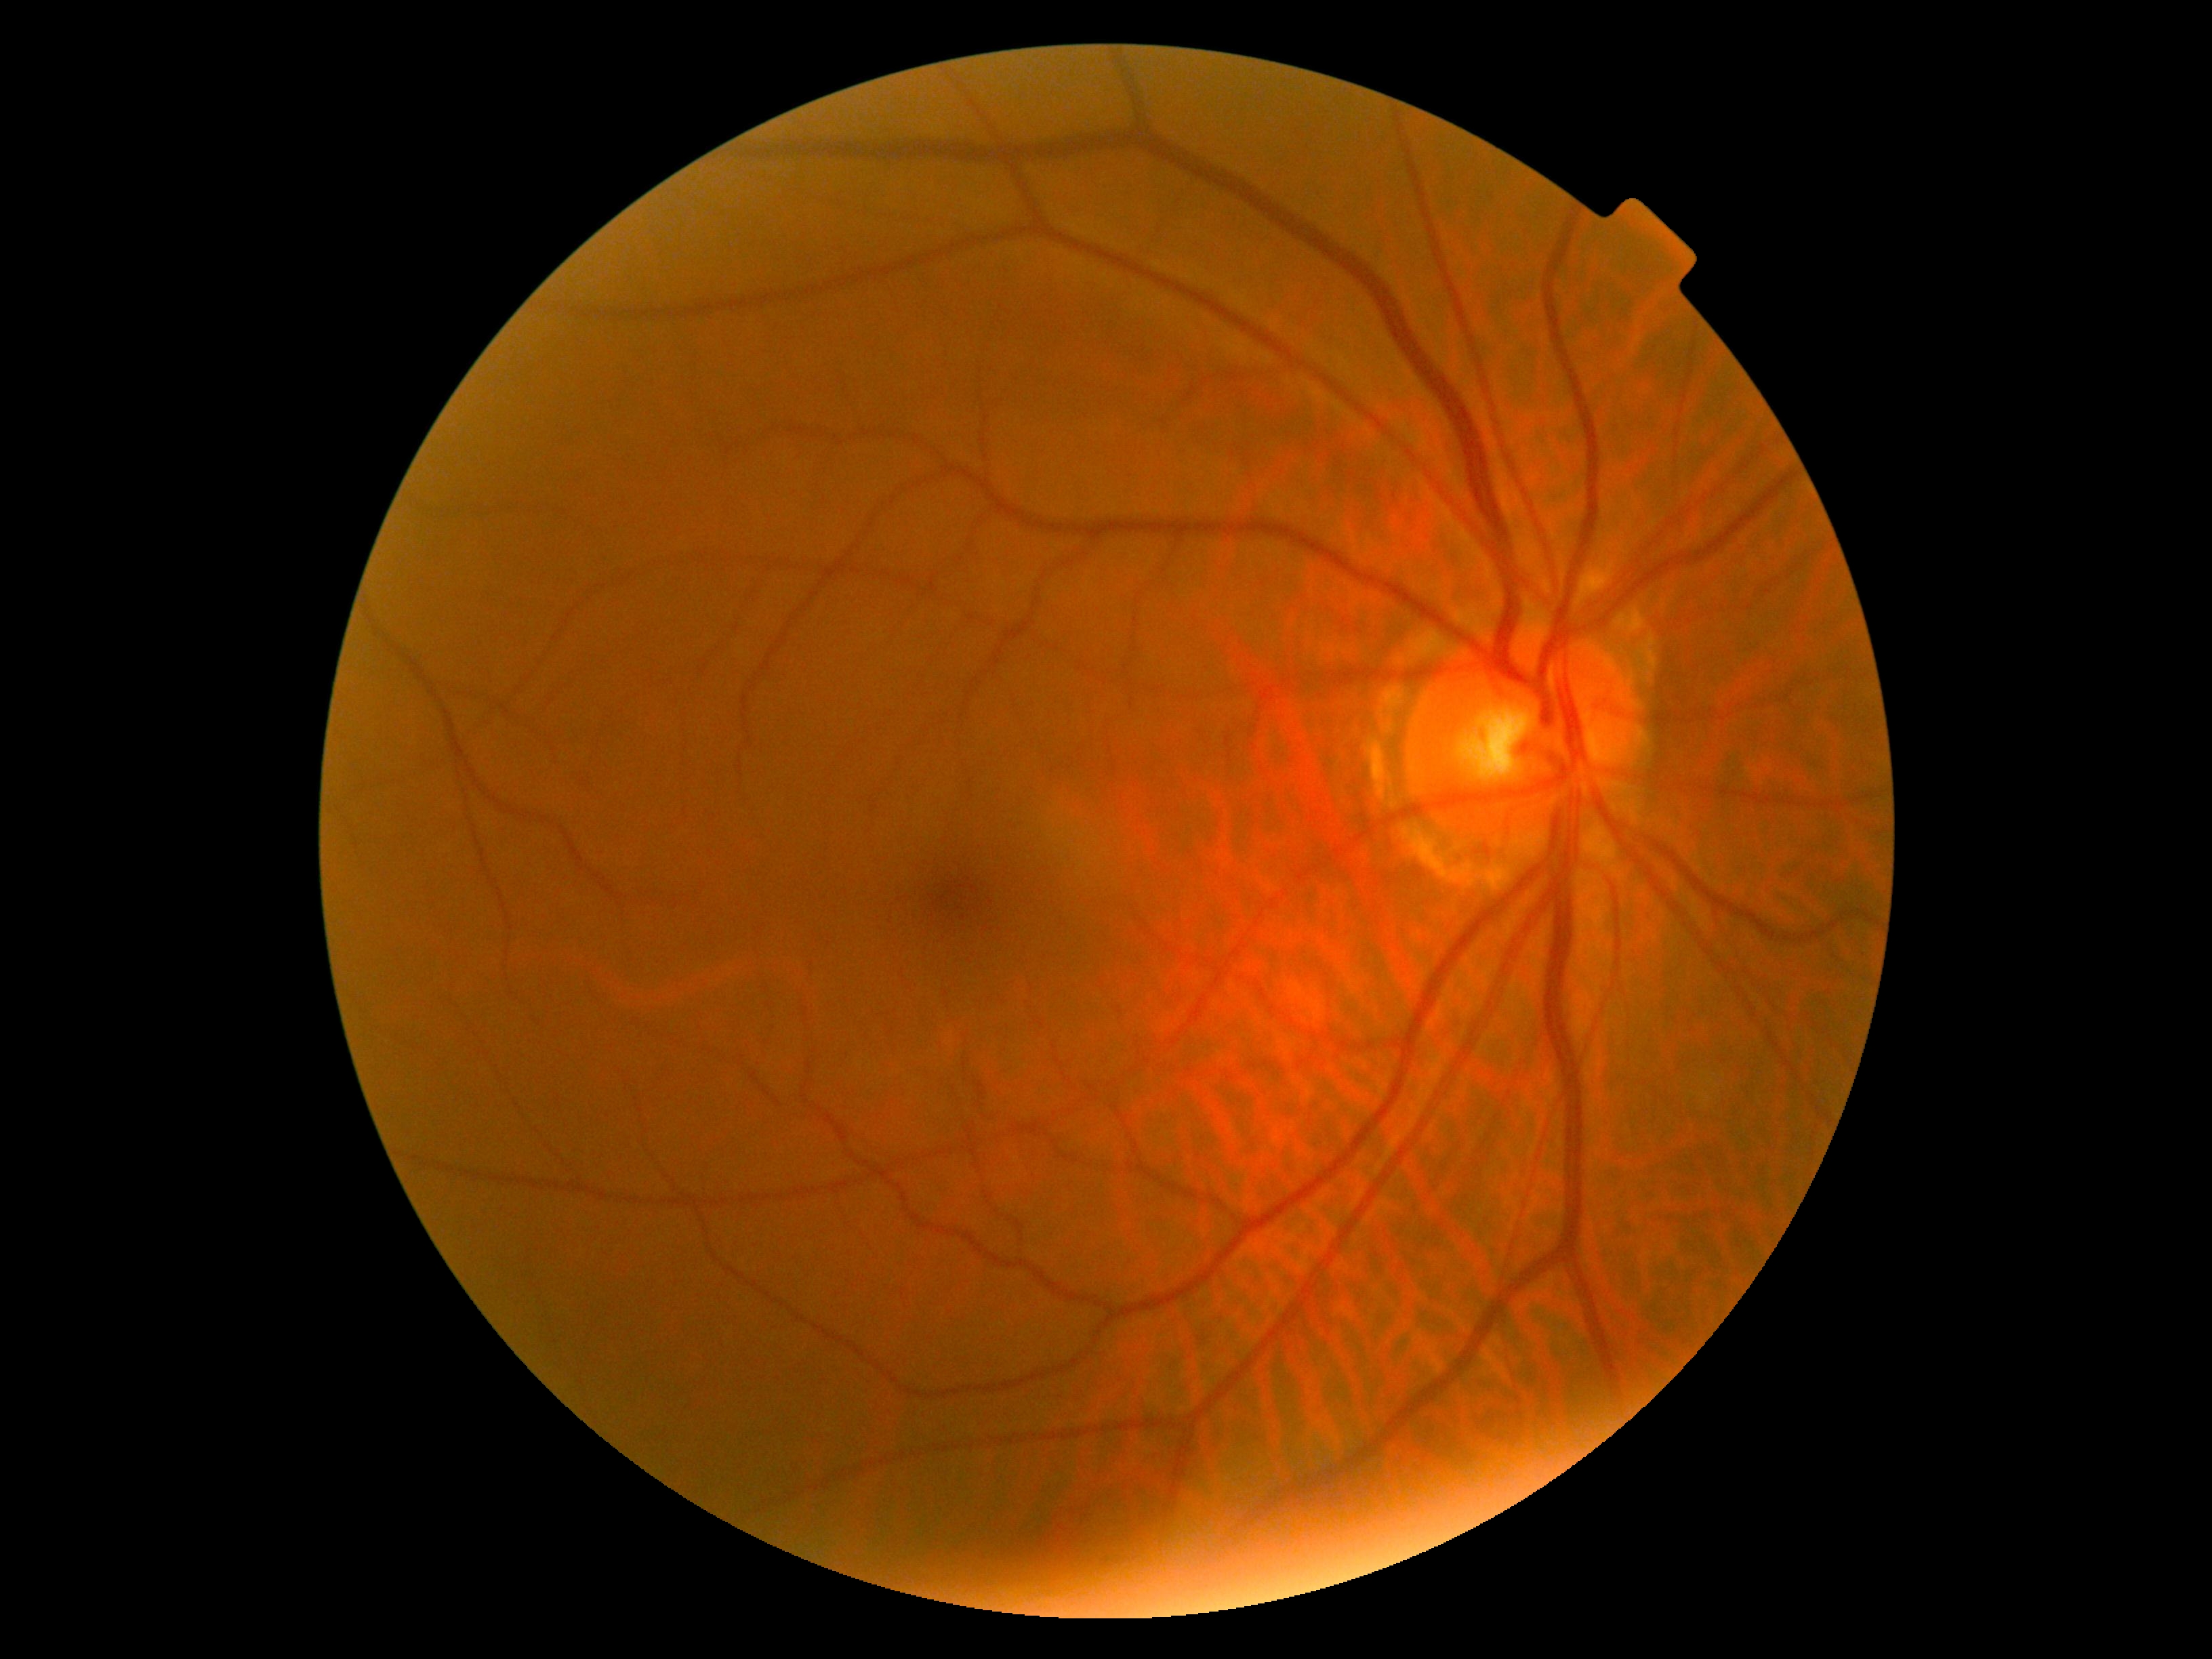 Diabetic retinopathy (DR) is 0/4.